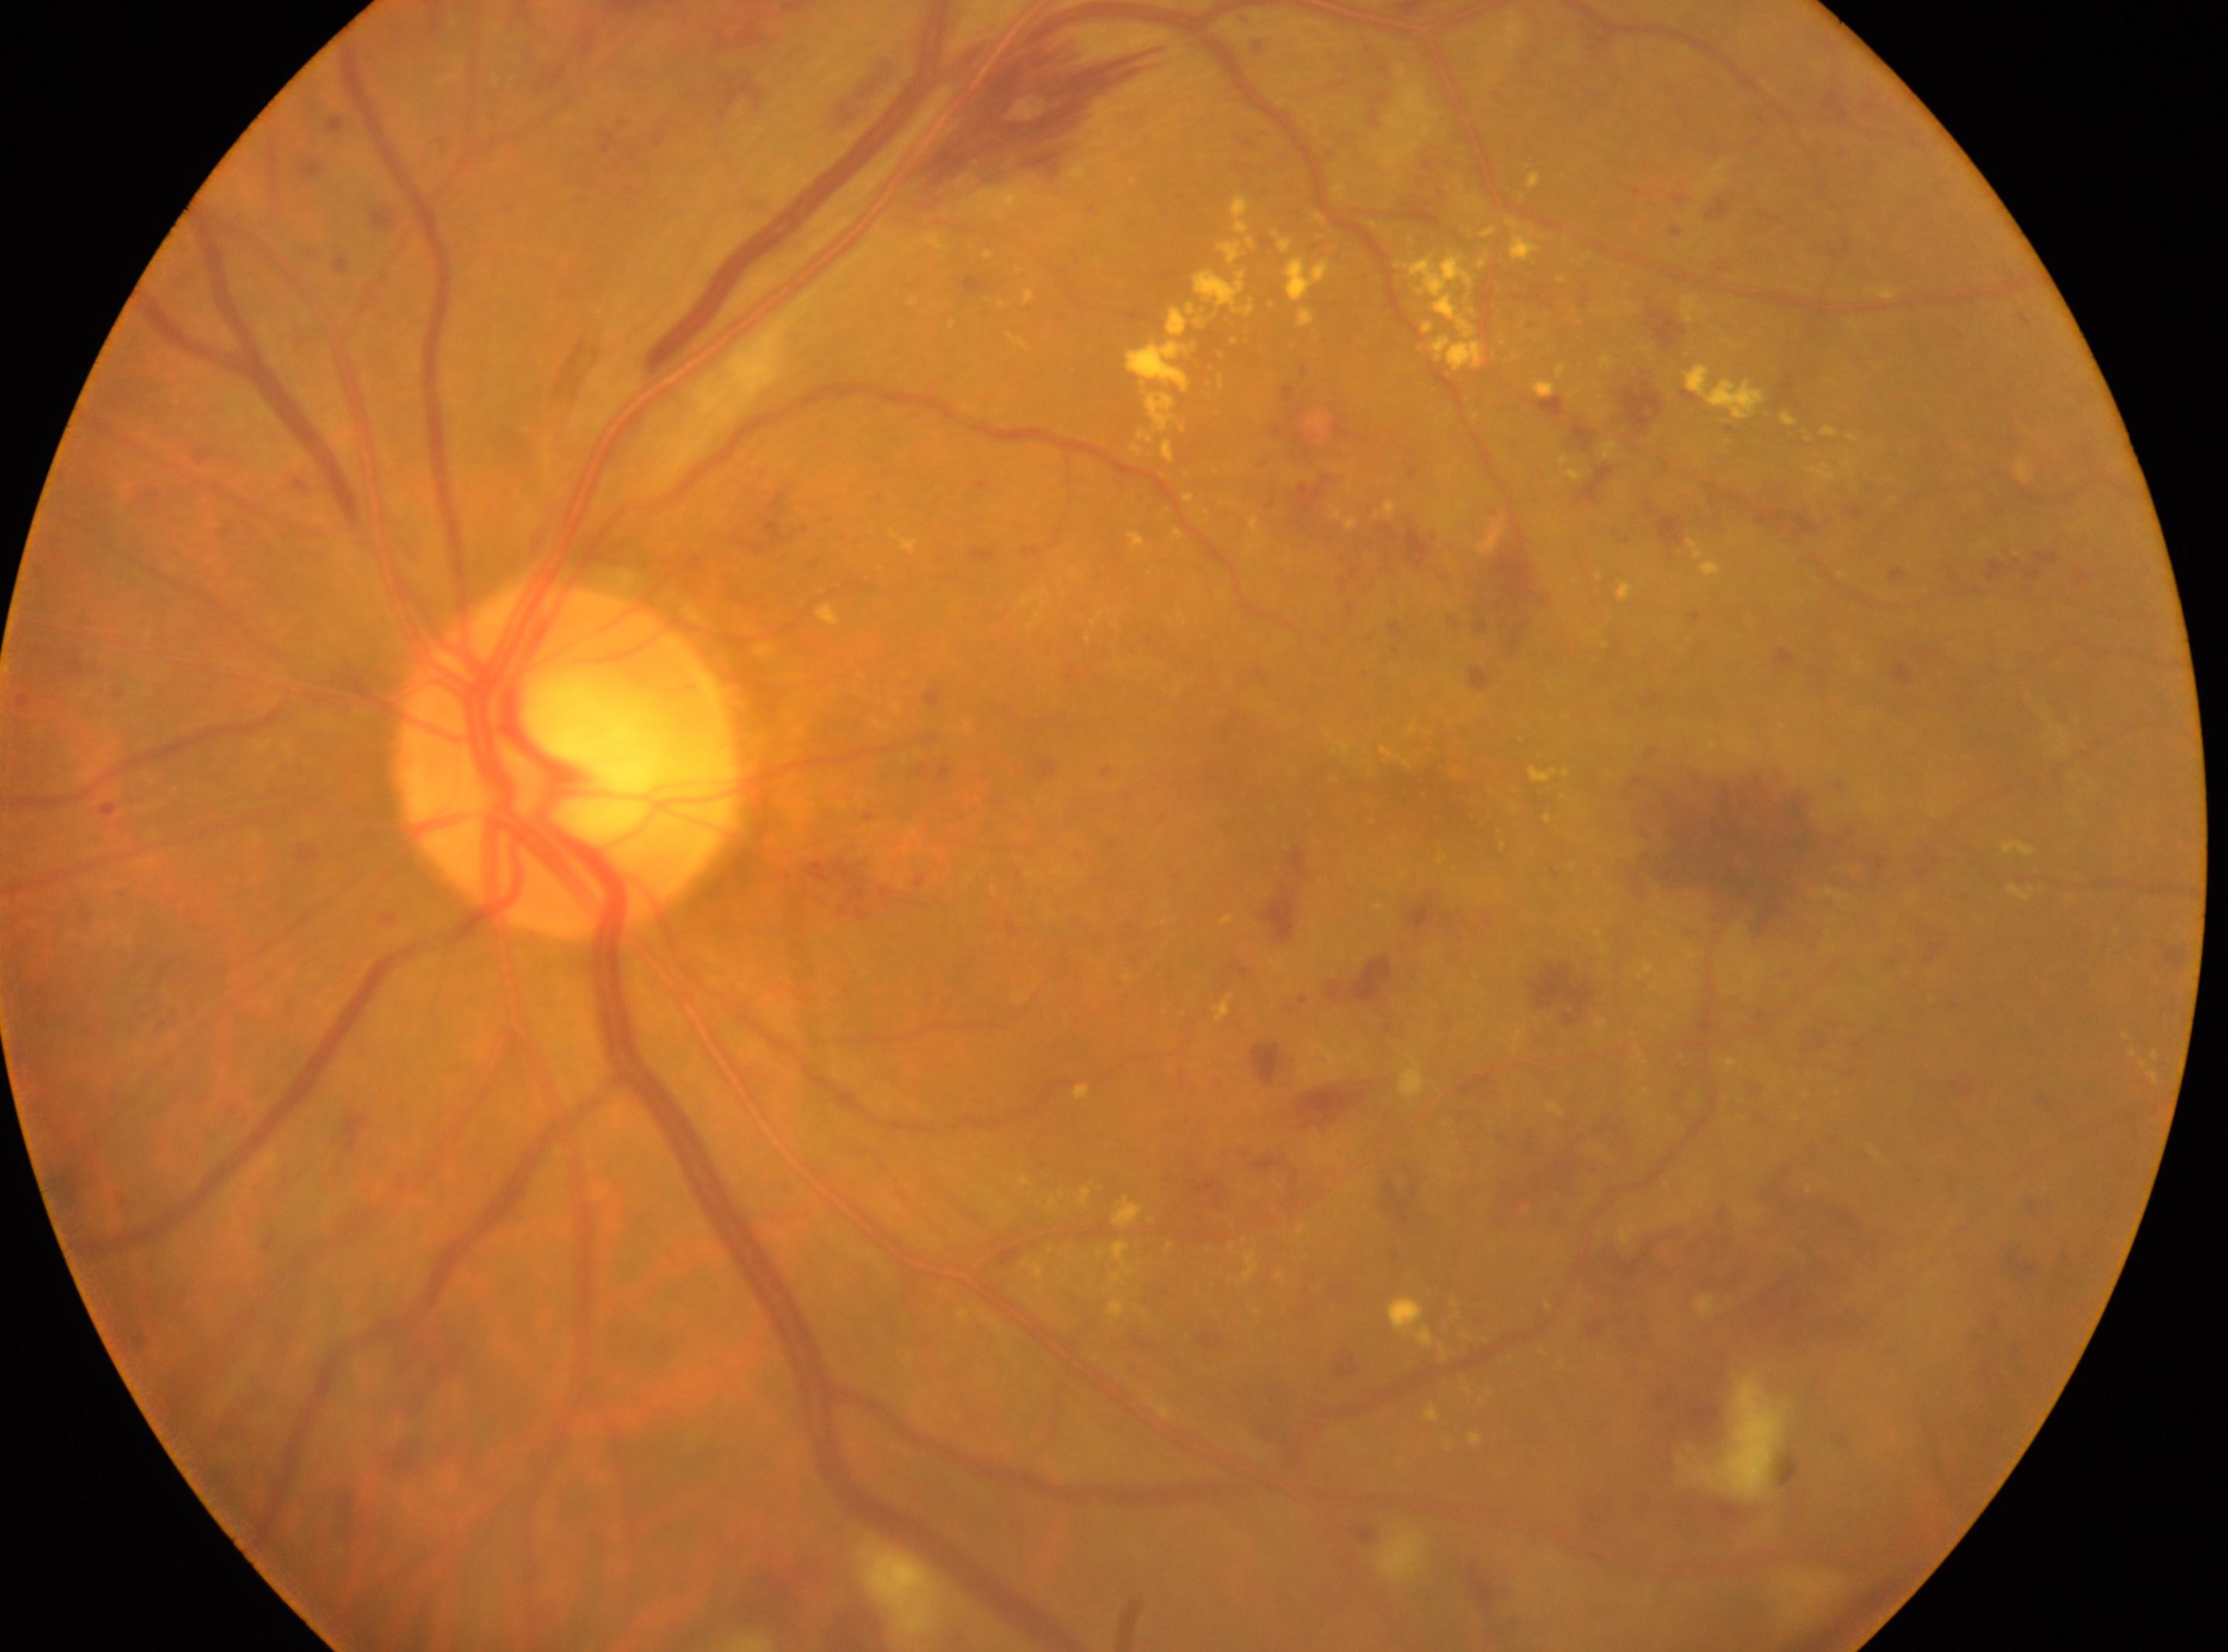

the fovea = x=1406, y=786; optic nerve head = x=565, y=759; retinopathy = severe non-proliferative diabetic retinopathy (grade 3) — more than 20 intraretinal hemorrhages in each of 4 quadrants, definite venous beading in 2 or more quadrants, or prominent intraretinal microvascular abnormalities in 1 or more quadrants, with no signs of proliferative retinopathy; laterality = left eye.